Optic nerve head photograph:
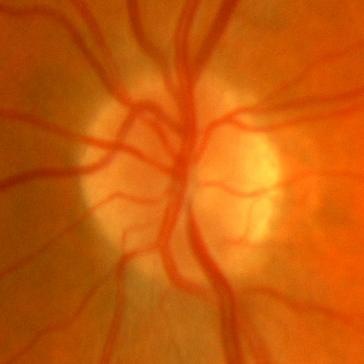 No glaucomatous optic neuropathy.